Pediatric wide-field fundus photograph. Camera: Phoenix ICON (100° FOV)
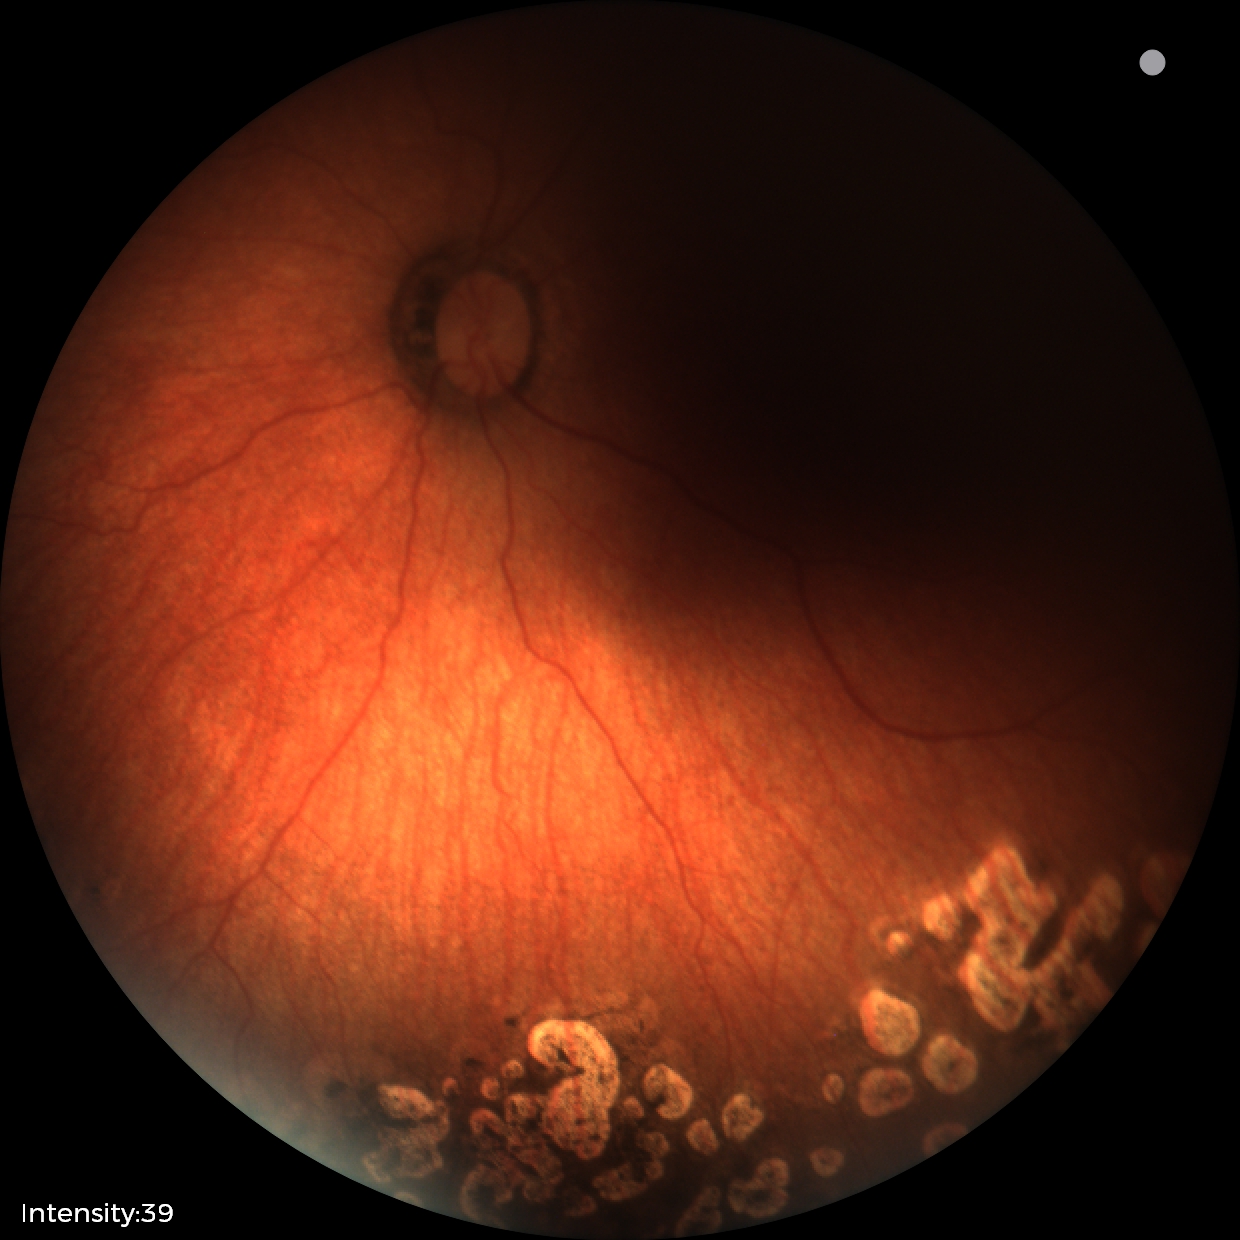
Screening series with status post retinopathy of prematurity (ROP) — retinal appearance after treated retinopathy of prematurity. No plus disease.